FOV: 45 degrees.
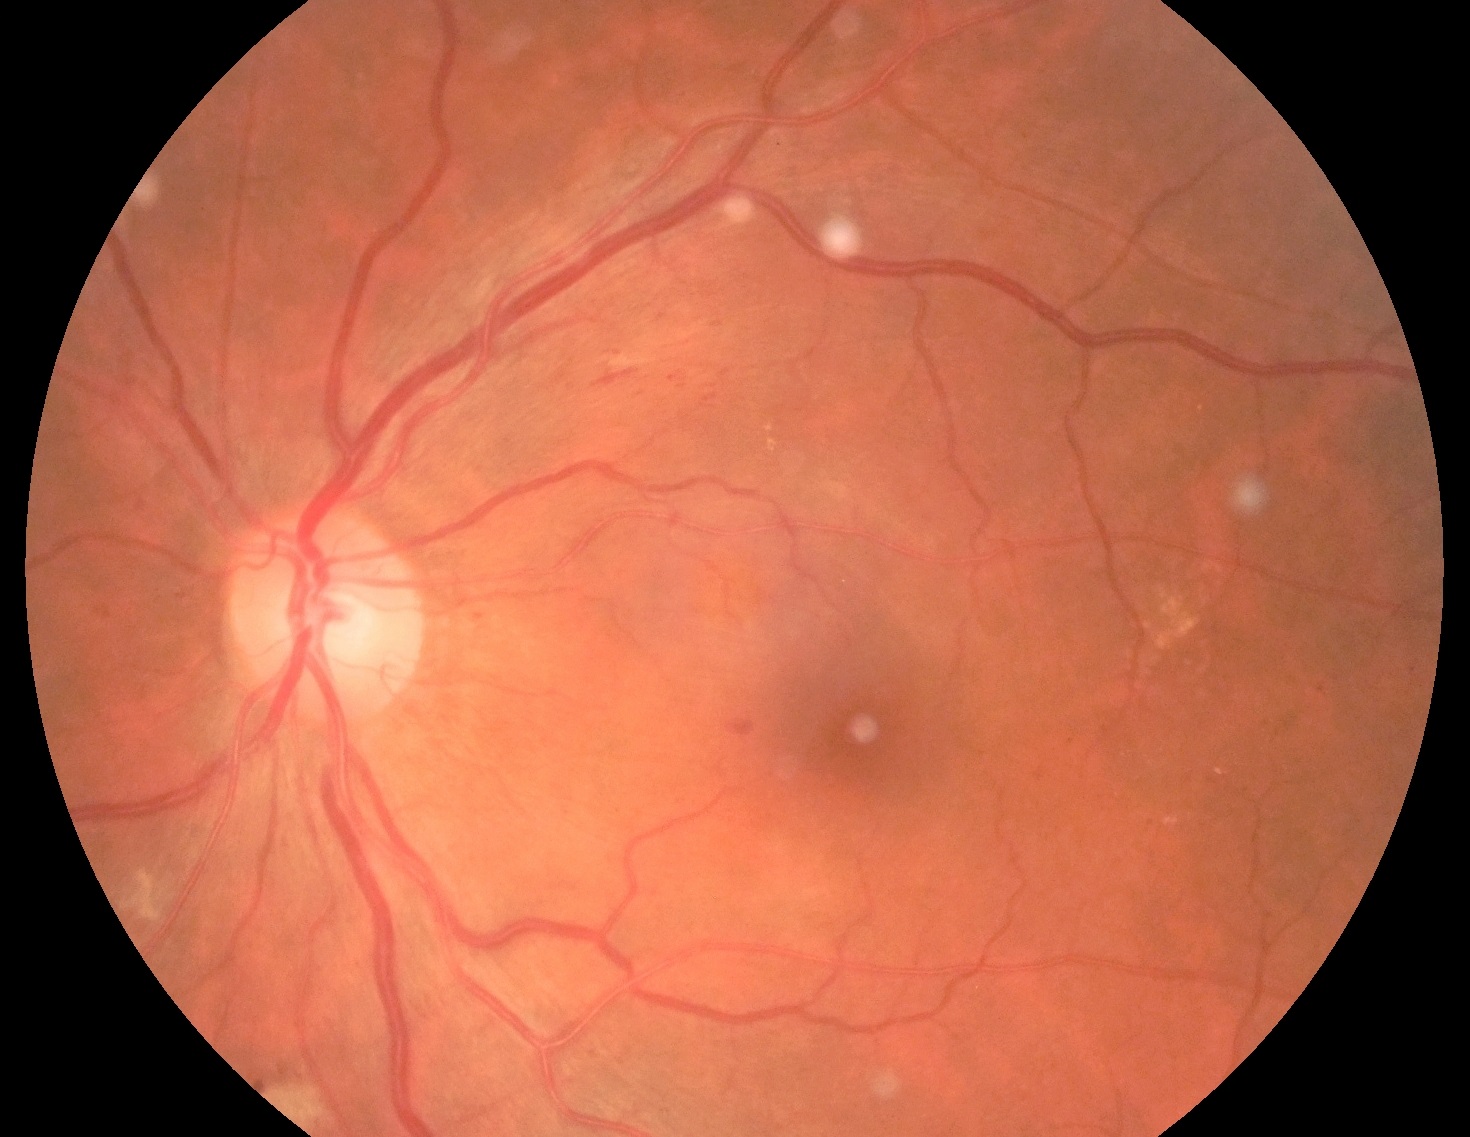

DR severity: moderate non-proliferative diabetic retinopathy (grade 2) — more than just microaneurysms but less than severe NPDR.